45° field of view
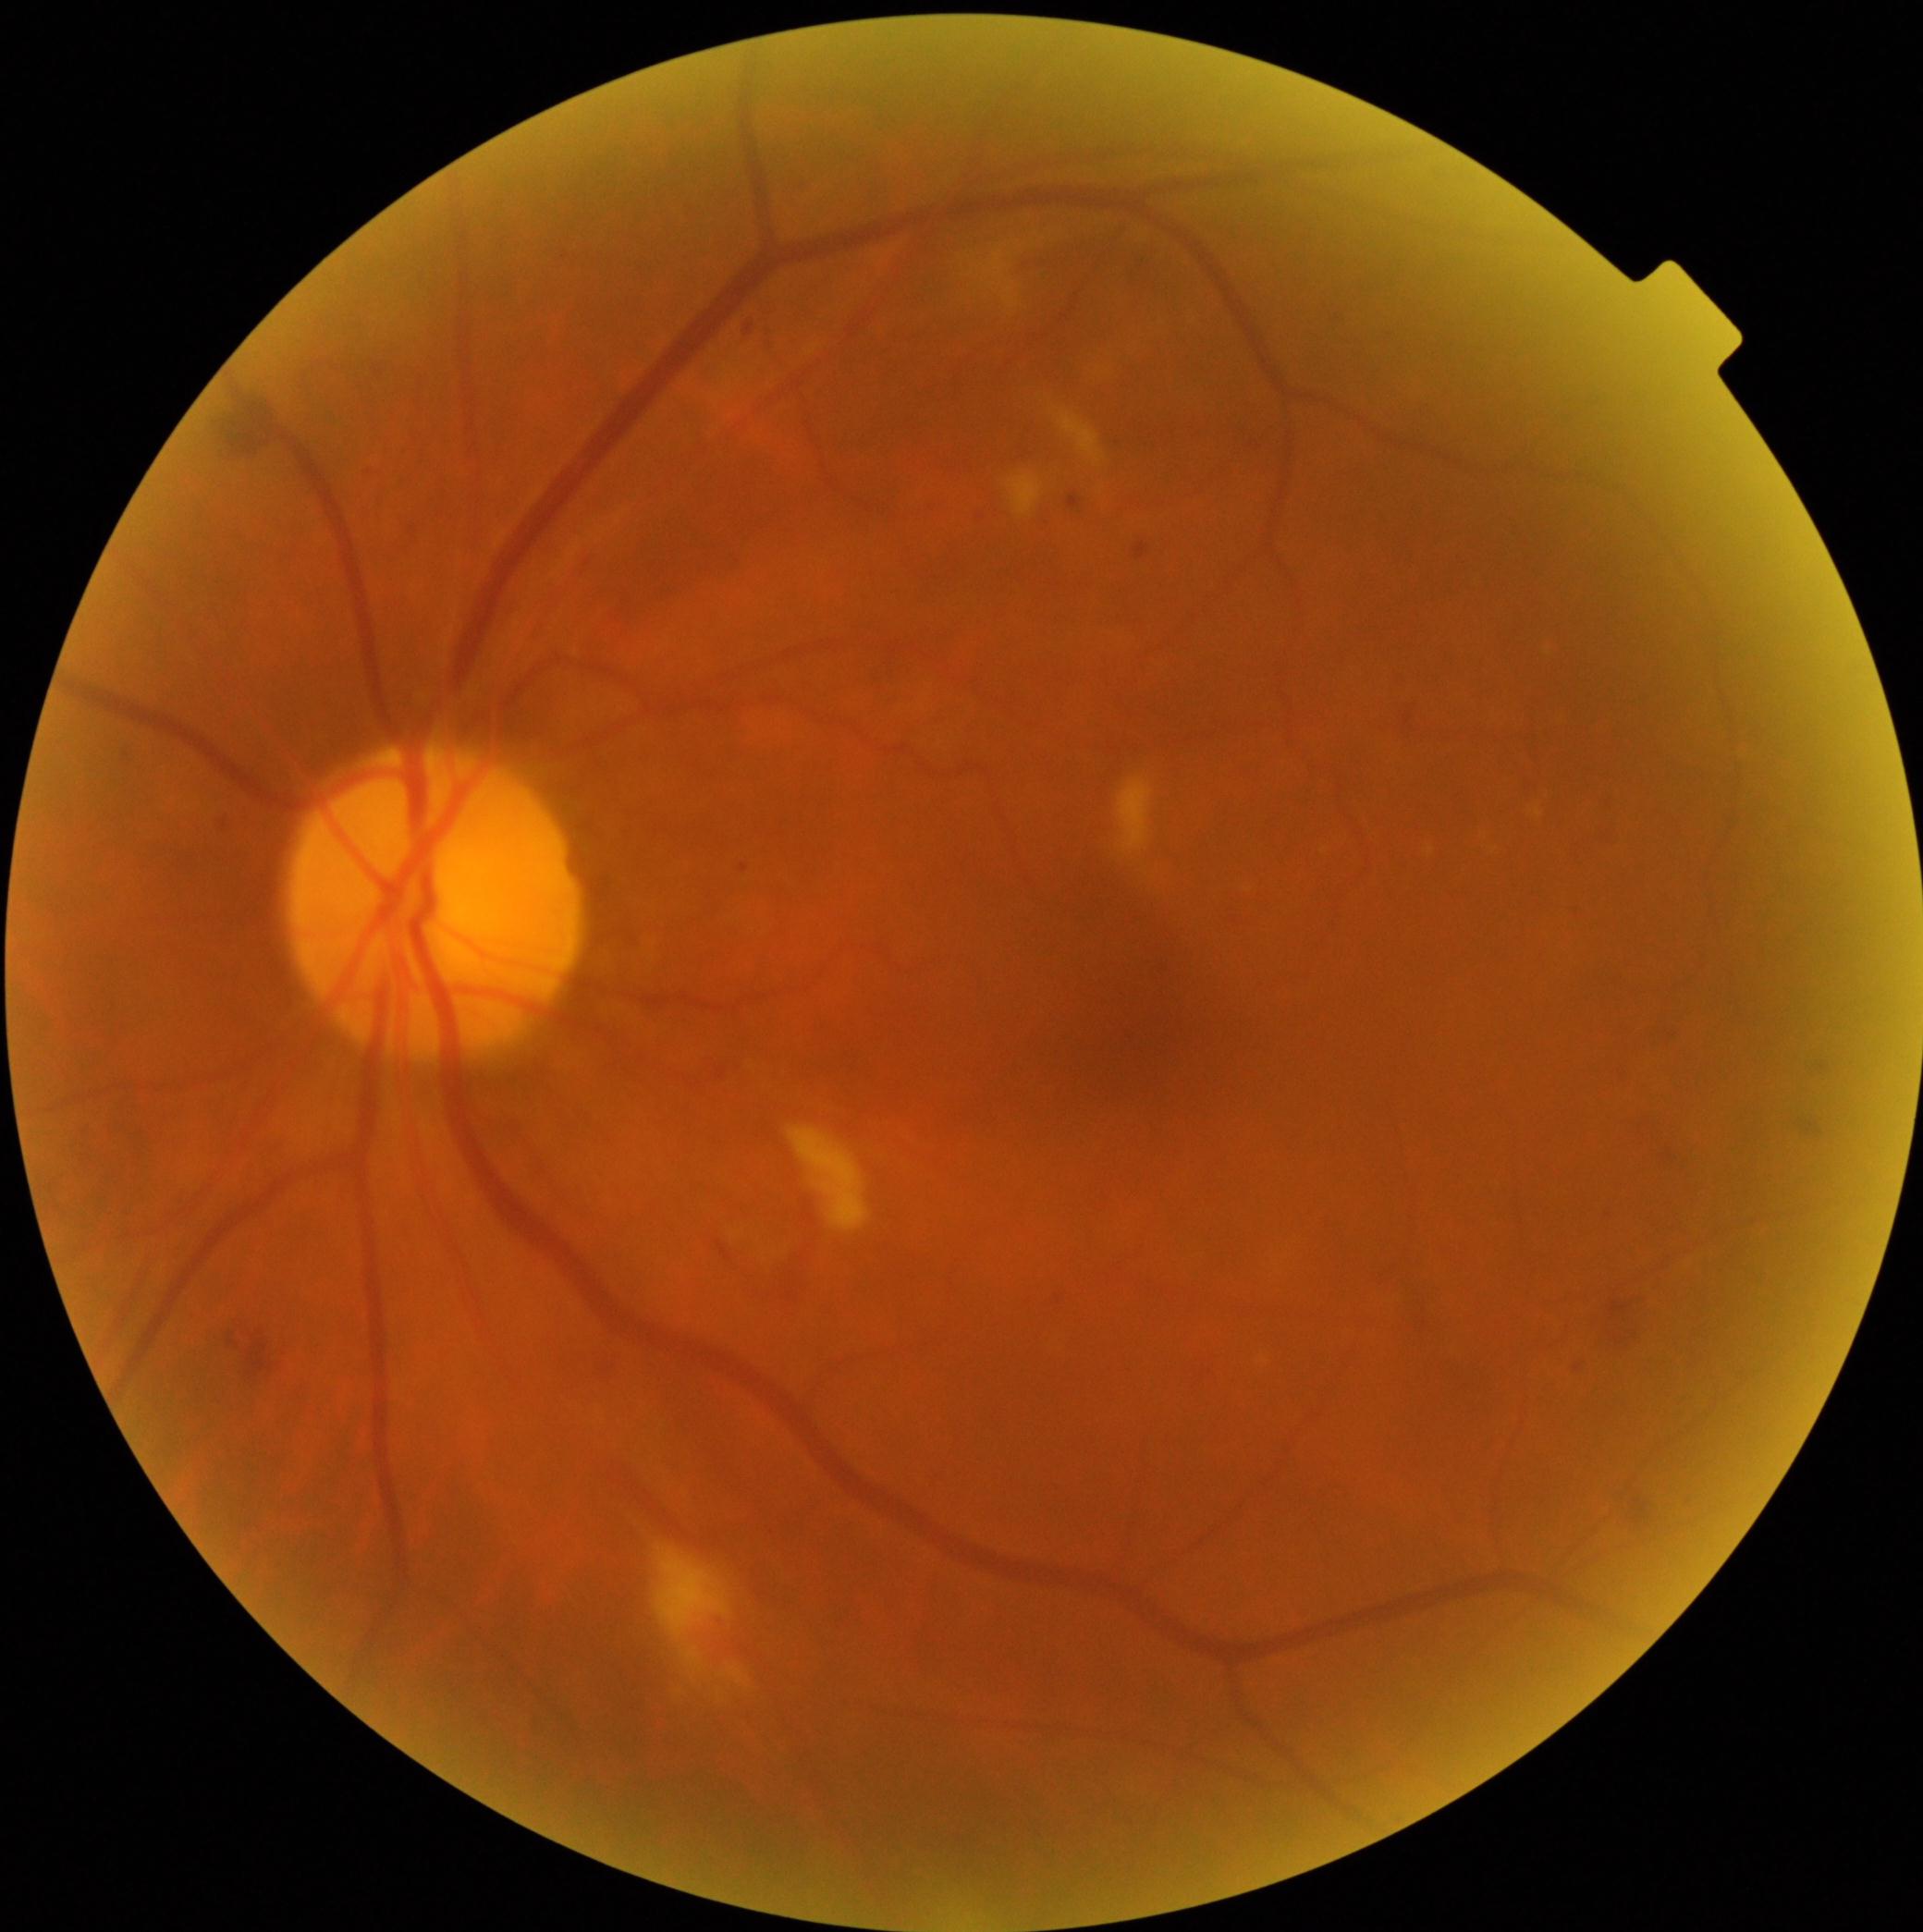

Diabetic retinopathy is grade 2 (moderate NPDR).